Camera: NIDEK AFC-230, nonmydriatic, 45-degree field of view, image size 848x848: 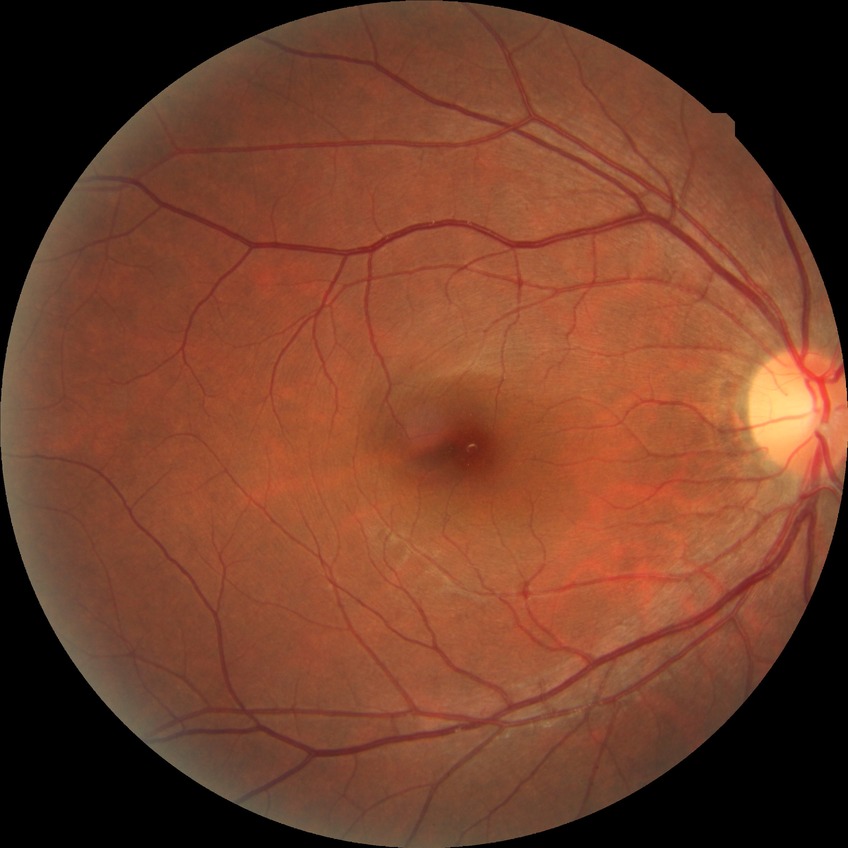 Diabetic retinopathy (DR): NDR (no diabetic retinopathy).